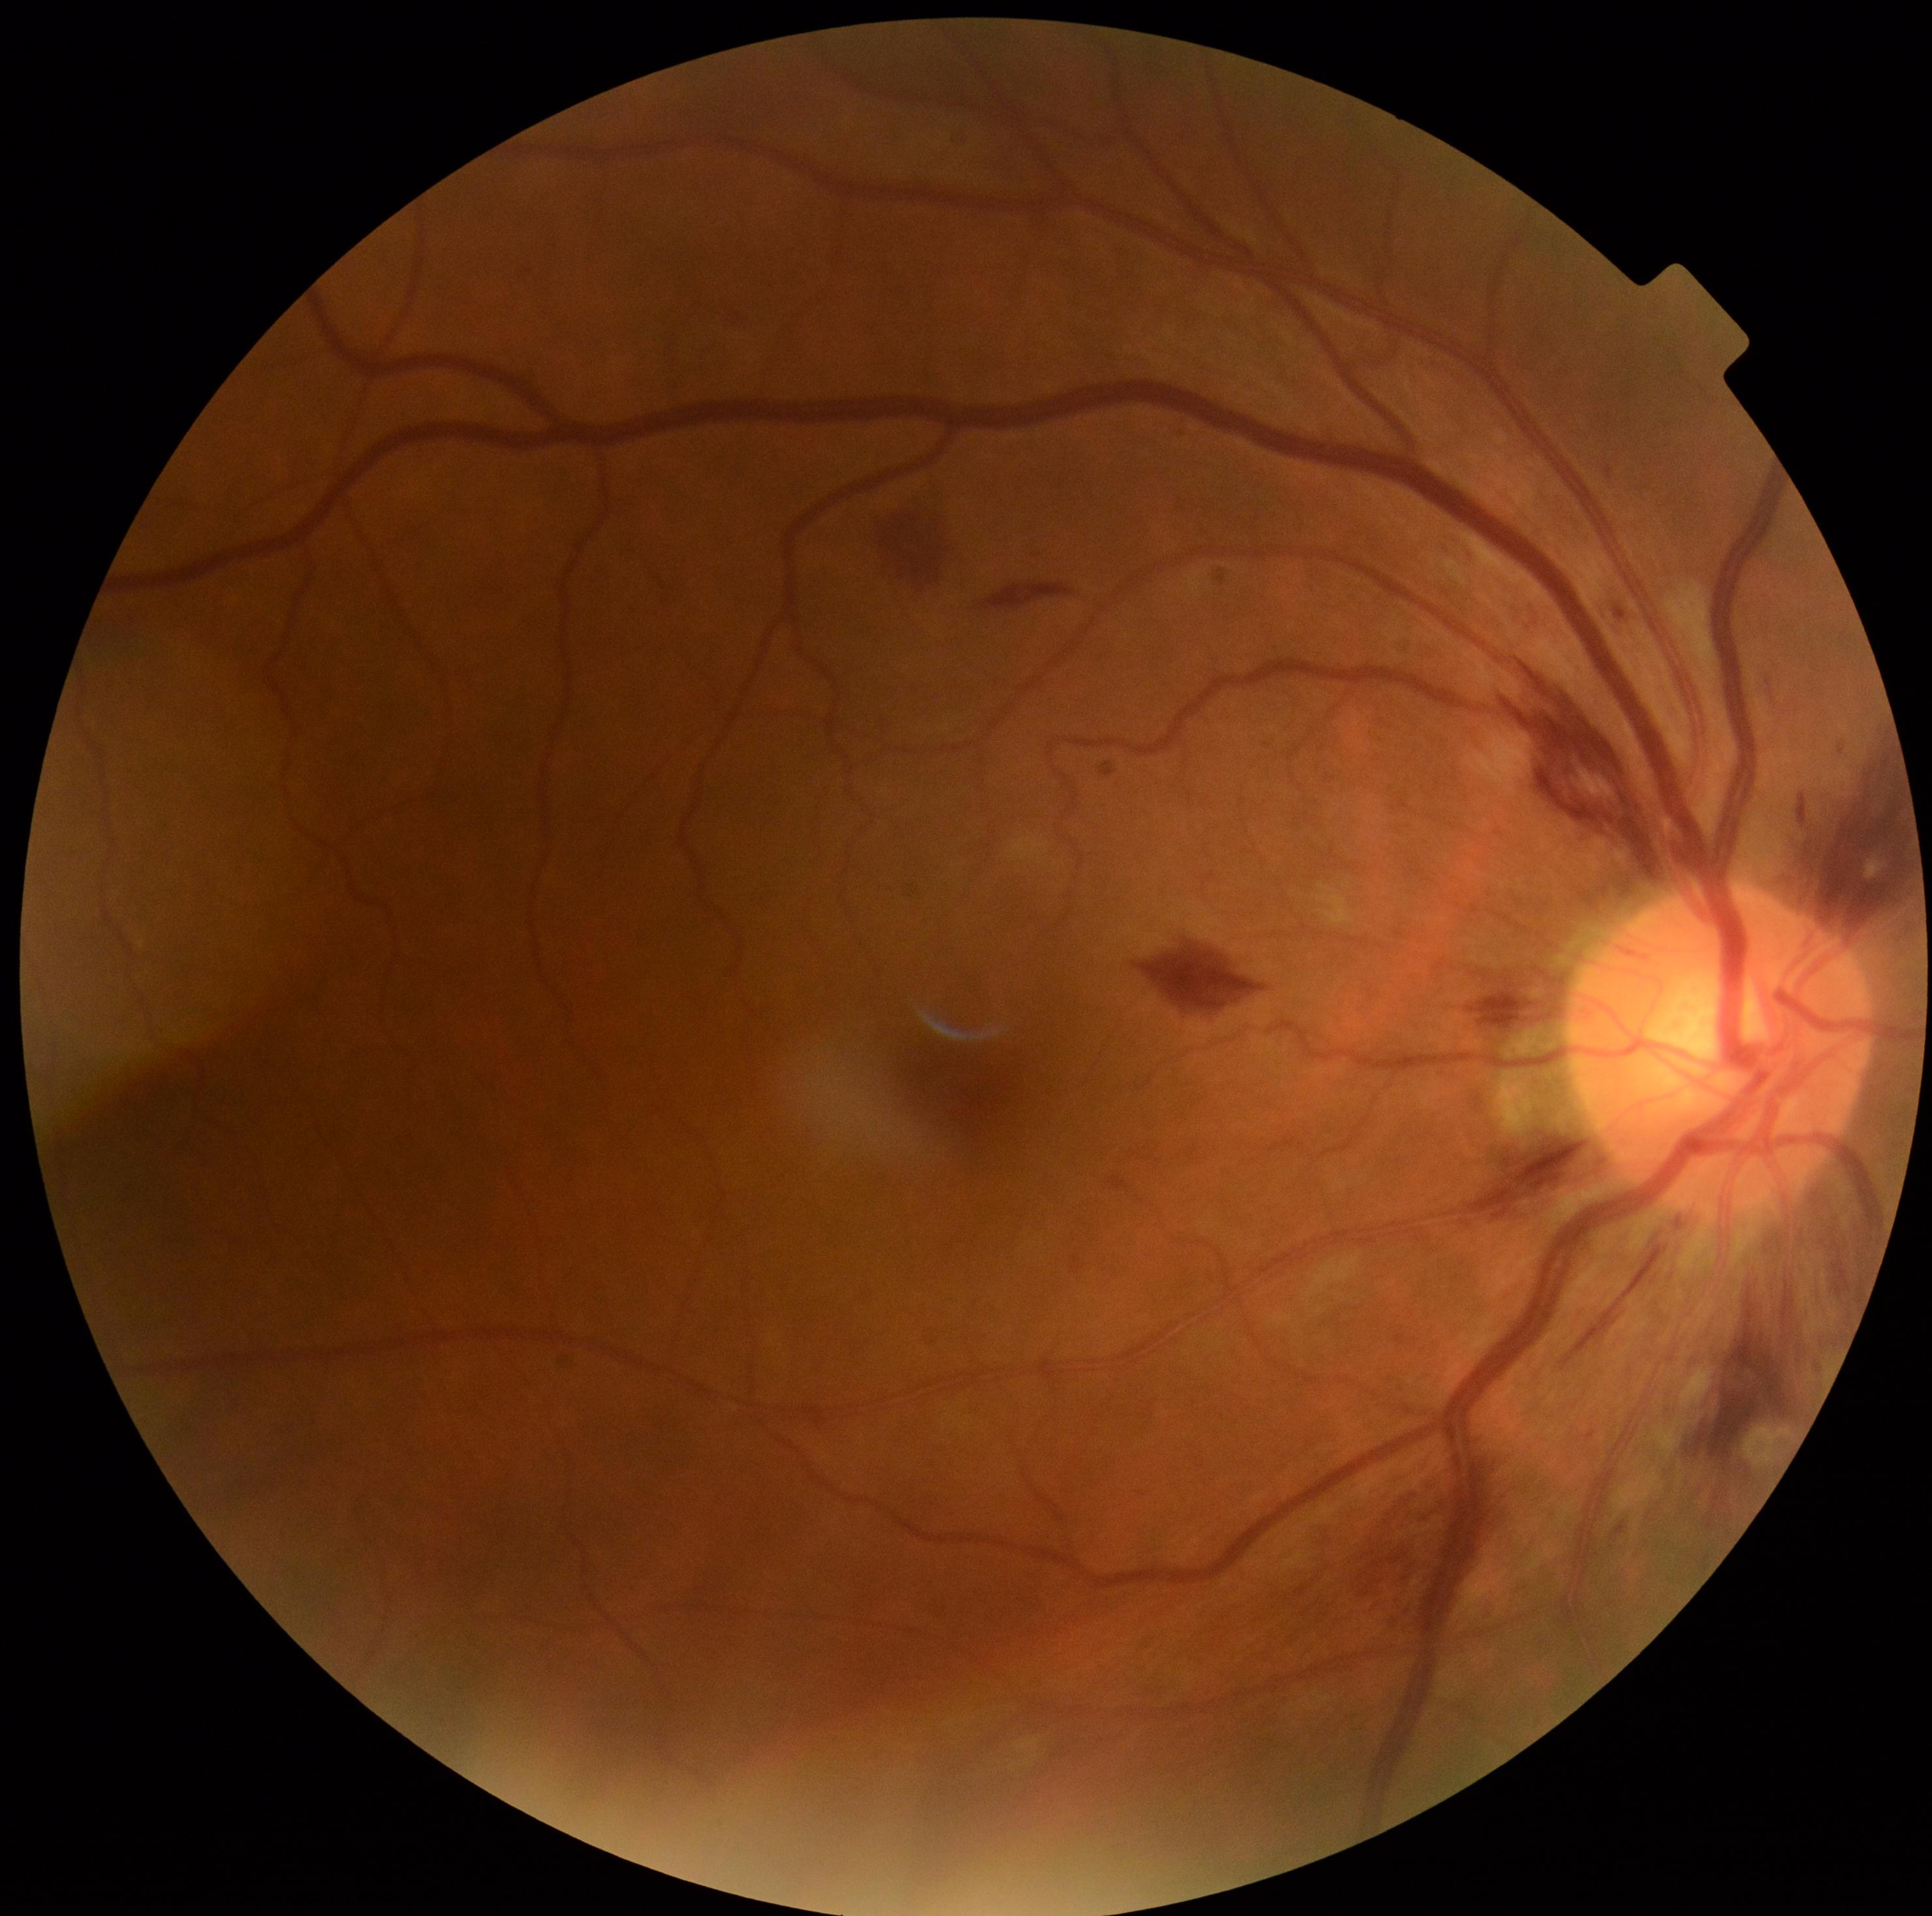
DR stage=2/4.